Acquired with a NIDEK AFC-230 · nonmydriatic · 45° FOV · image size 848x848 · Davis DR grading:
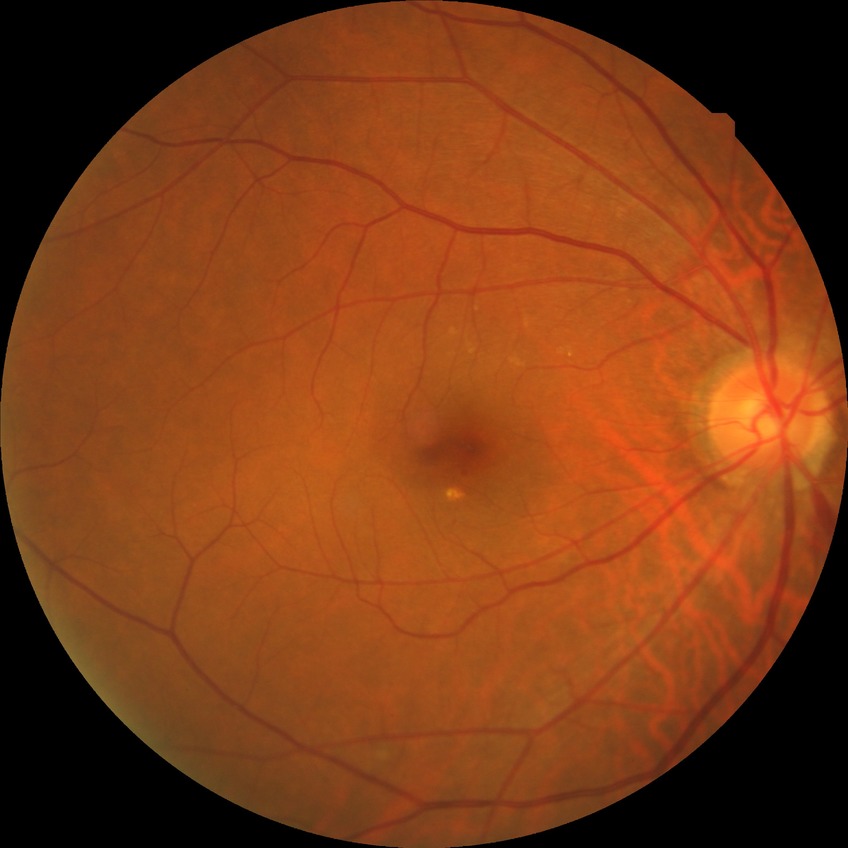

Diabetic retinopathy grade: simple diabetic retinopathy.